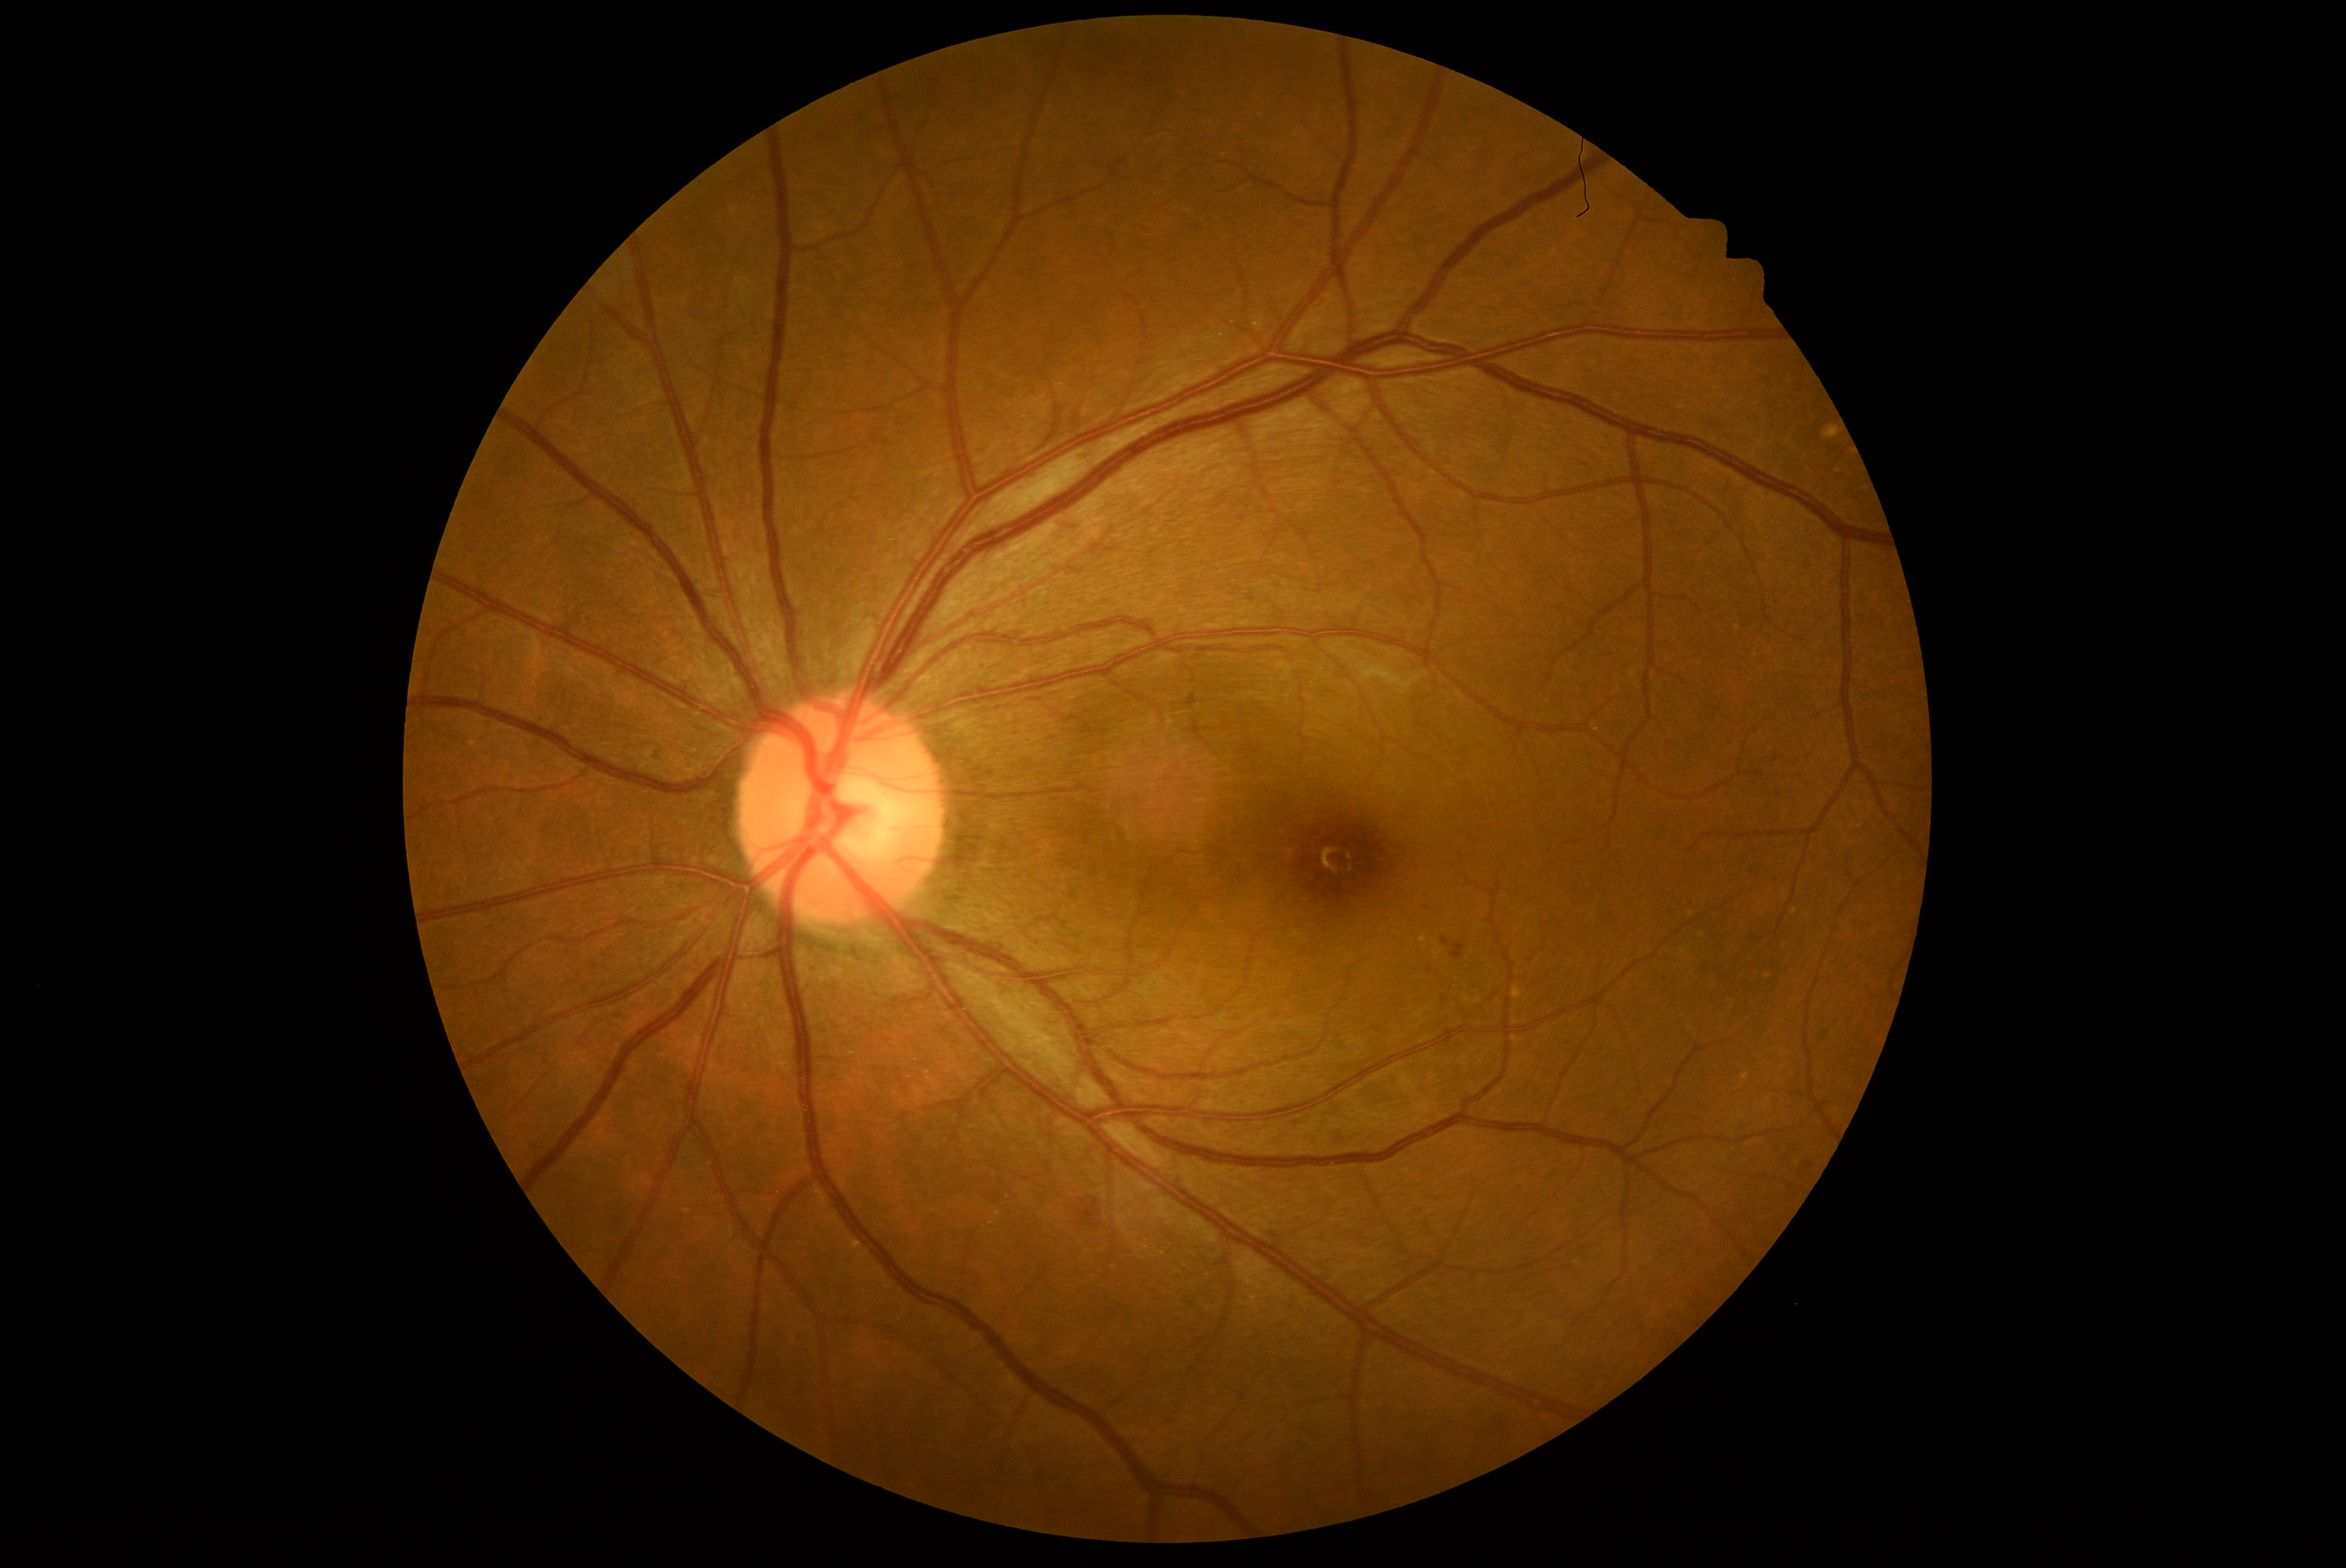
Diabetic retinopathy (DR) is moderate non-proliferative diabetic retinopathy (grade 2).